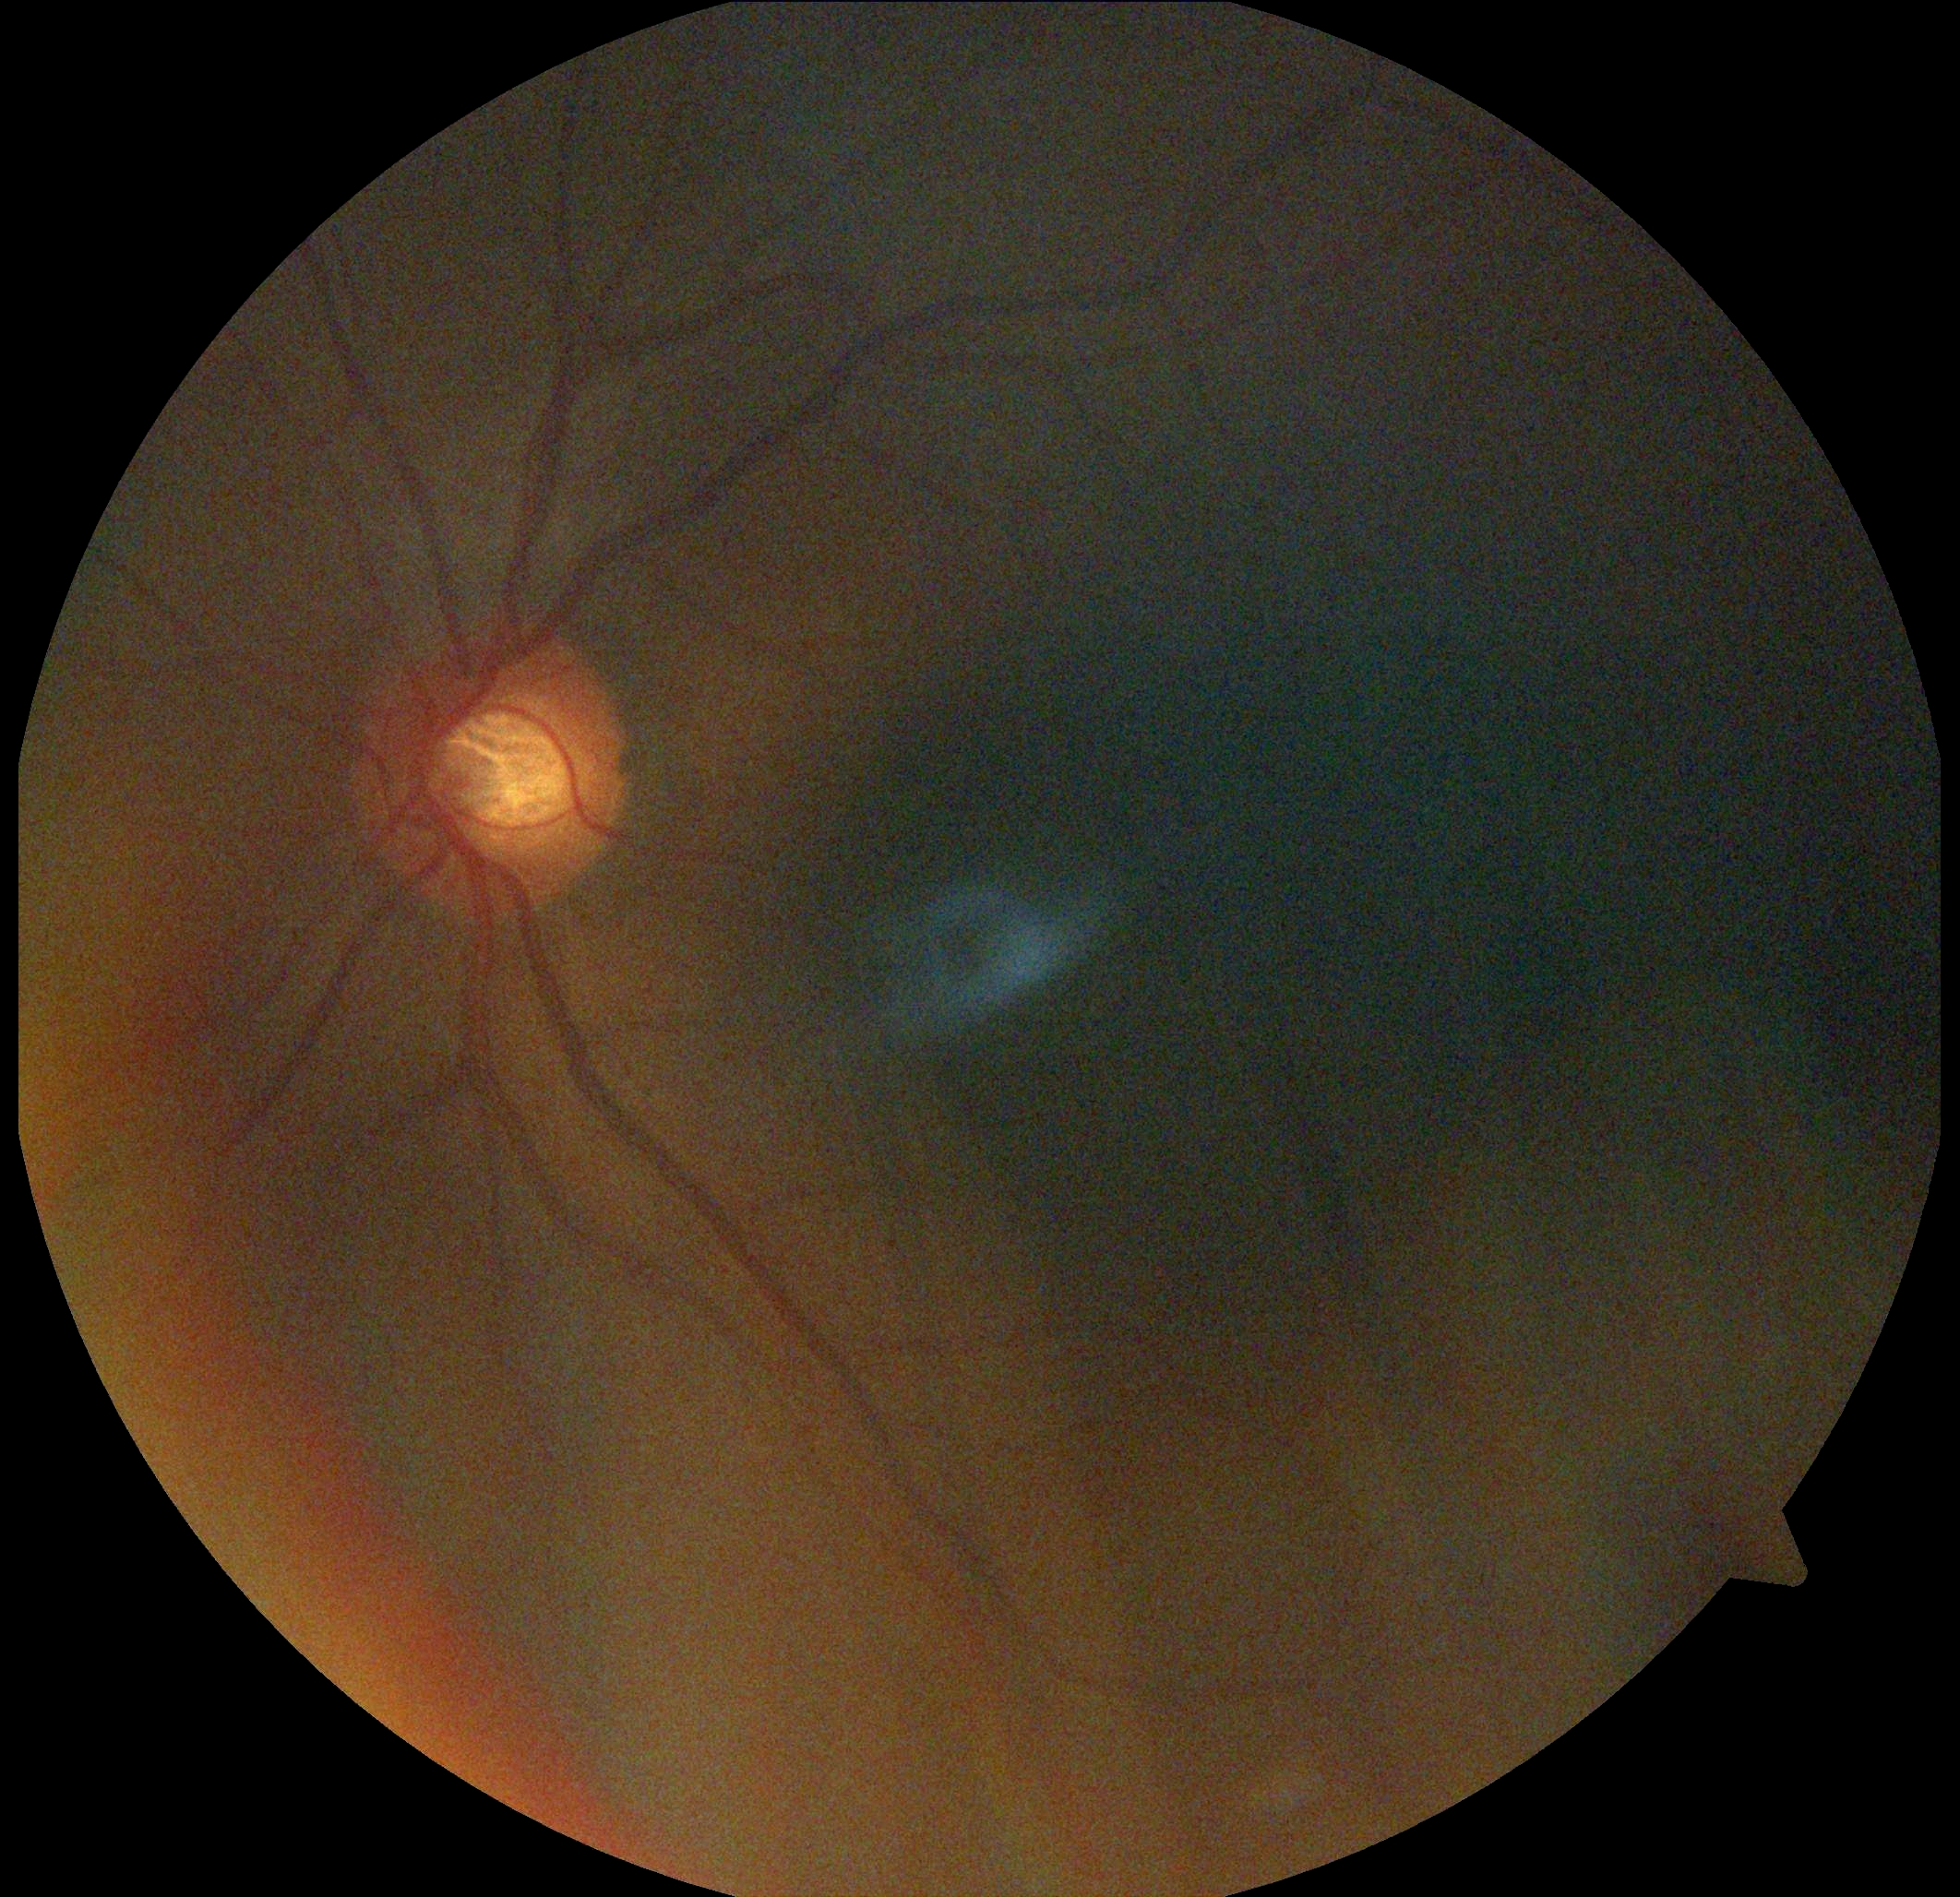

{
  "dr_grade": "grade 0 (no apparent retinopathy) — no visible signs of diabetic retinopathy"
}